848x848px — 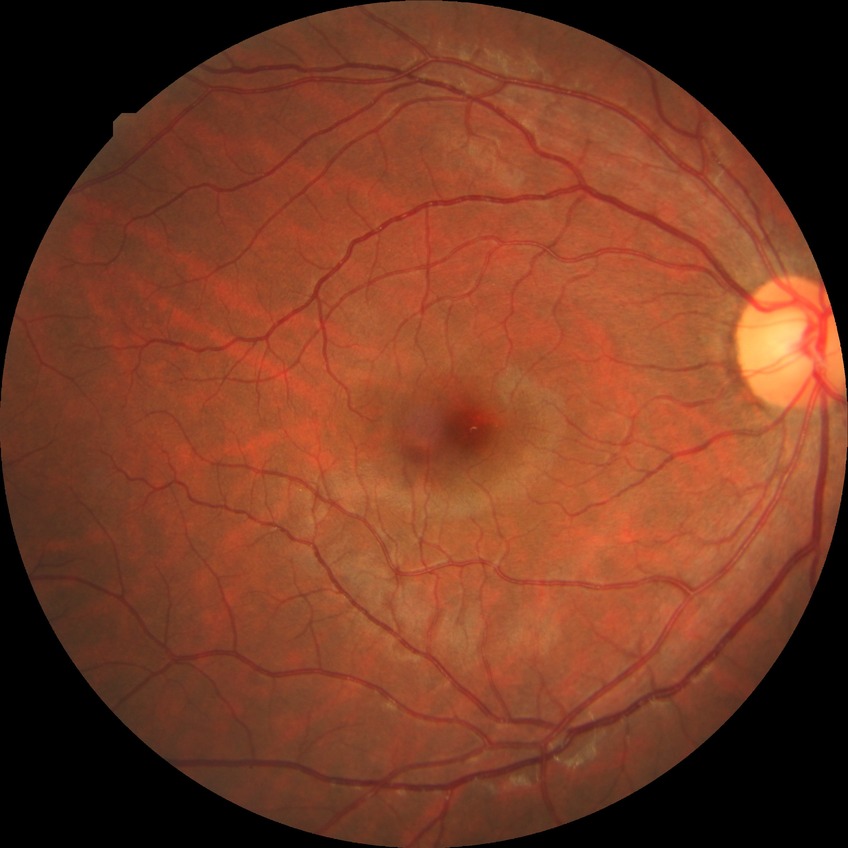 Diabetic retinopathy (DR): no diabetic retinopathy (NDR).